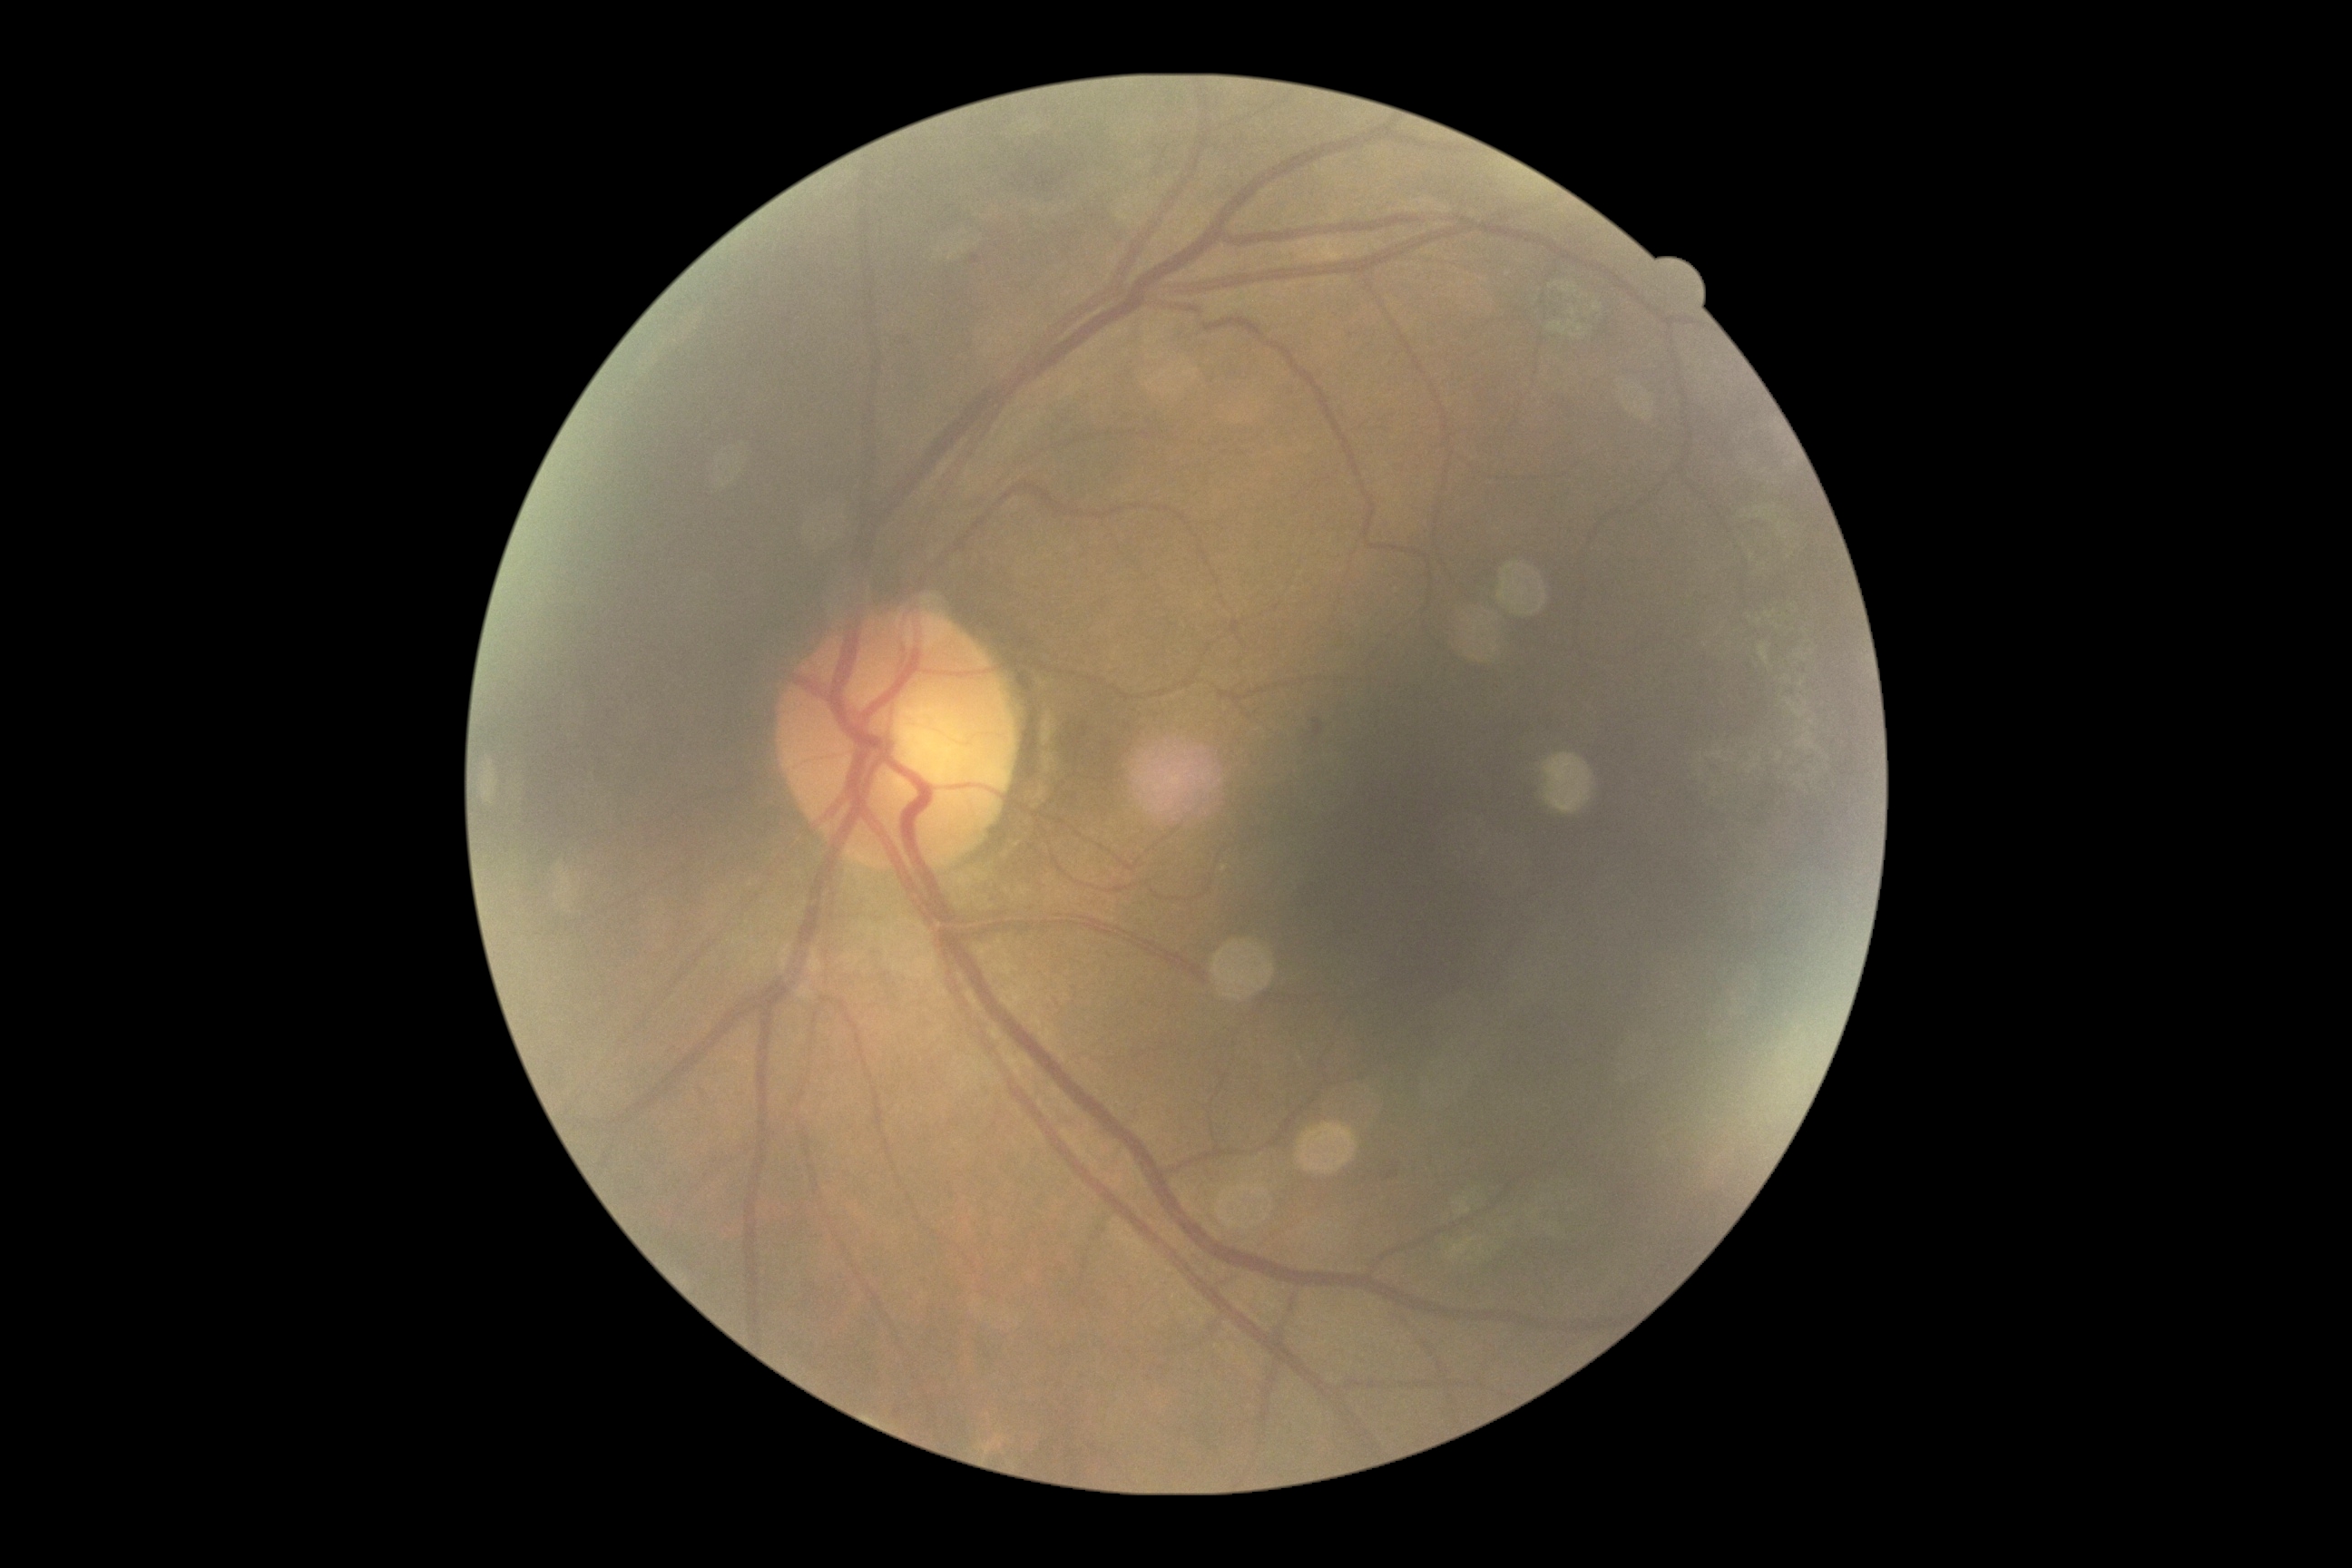
DR grade: moderate non-proliferative diabetic retinopathy (2).